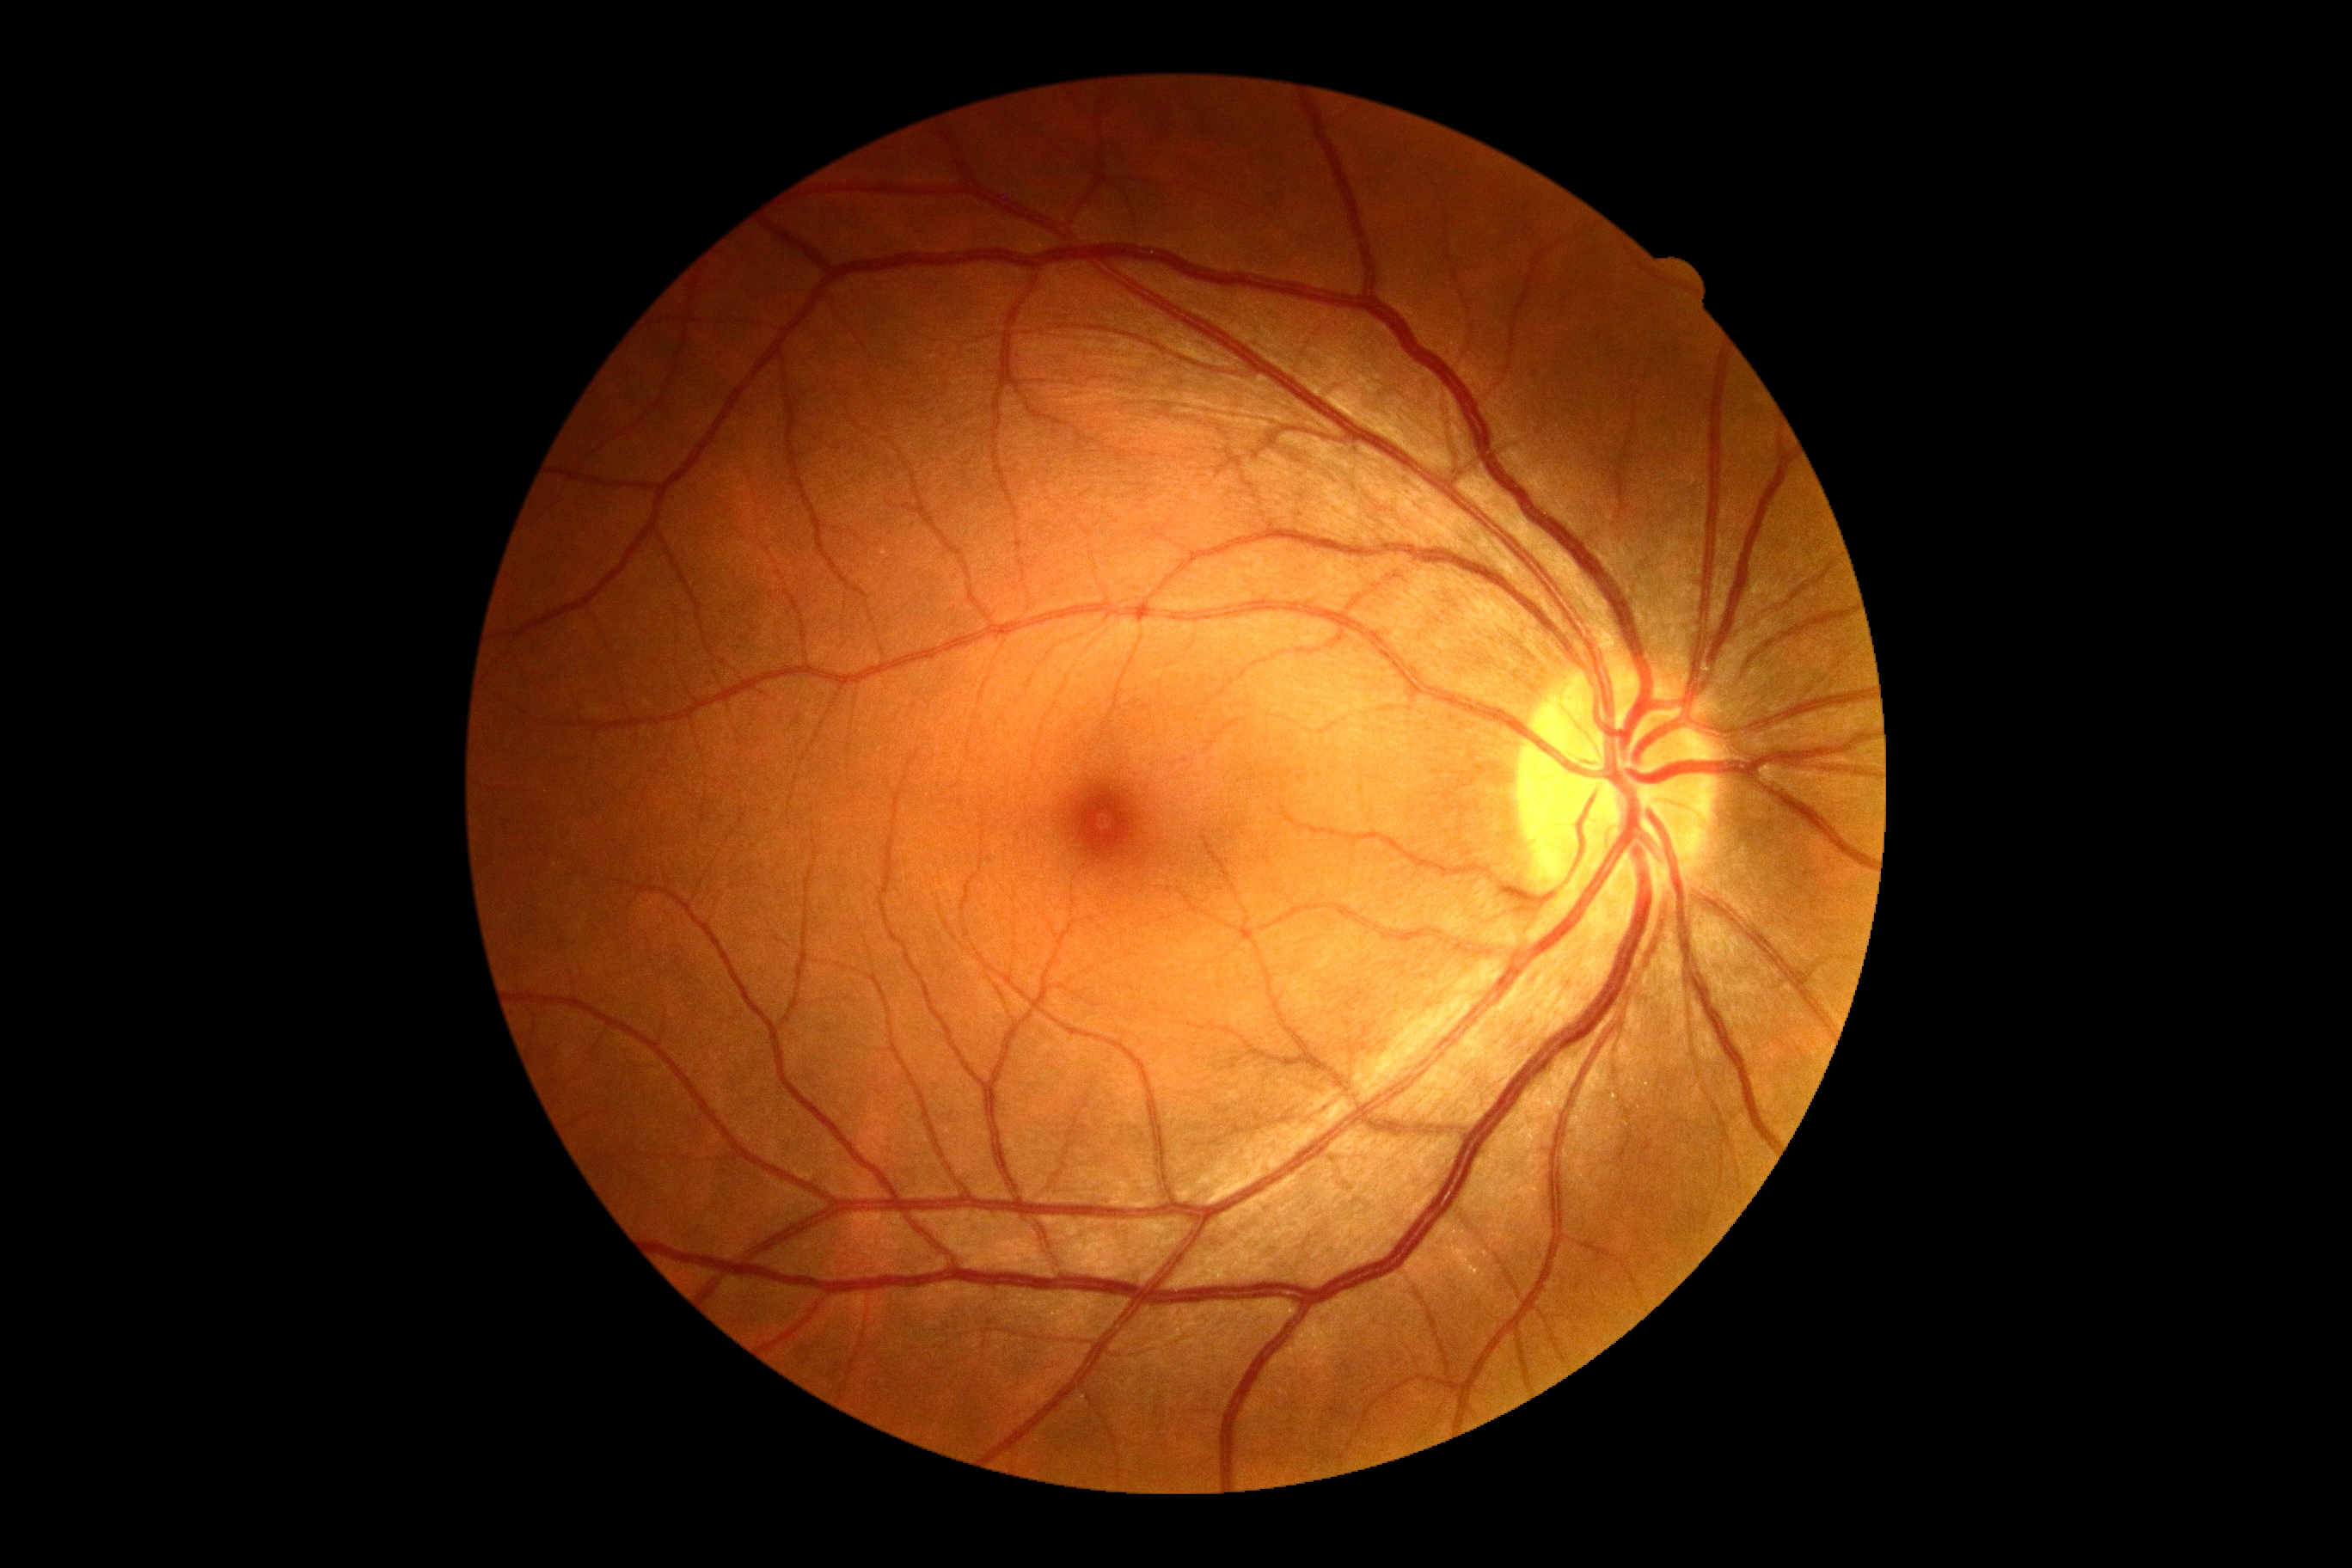 No DR findings. Retinopathy: no apparent diabetic retinopathy (grade 0).